45-degree field of view: 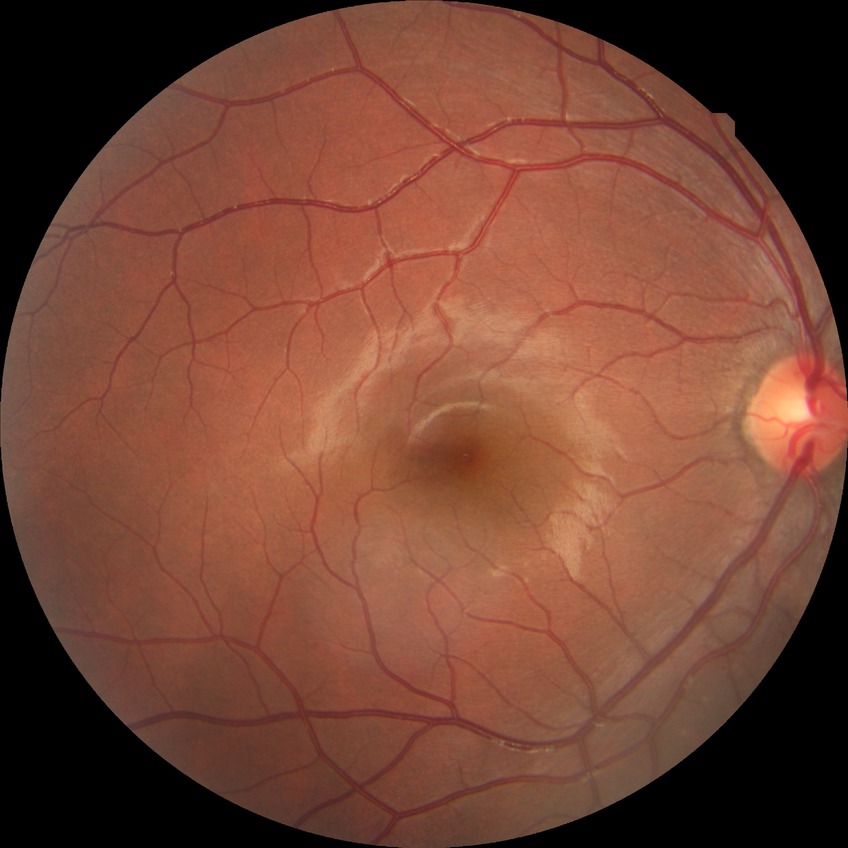

Retinopathy grade is no diabetic retinopathy.